Acquired on the Clarity RetCam 3 · 640 x 480 pixels · wide-field contact fundus photograph of an infant:
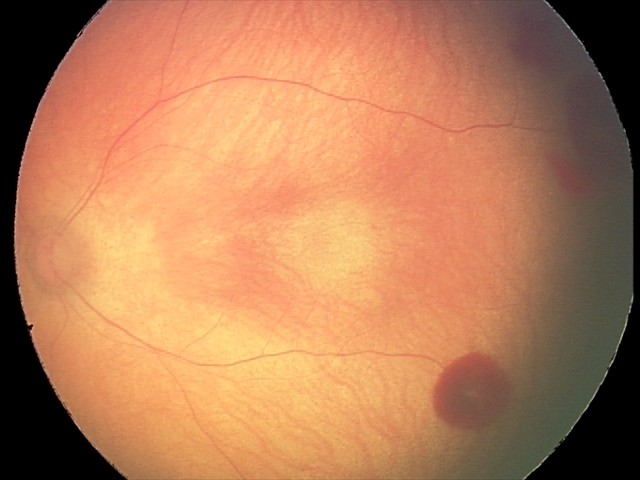
Screening: retinal hemorrhages.